Posterior pole color fundus photograph. Graded on the modified Davis scale. Without pupil dilation. 45 degree fundus photograph: 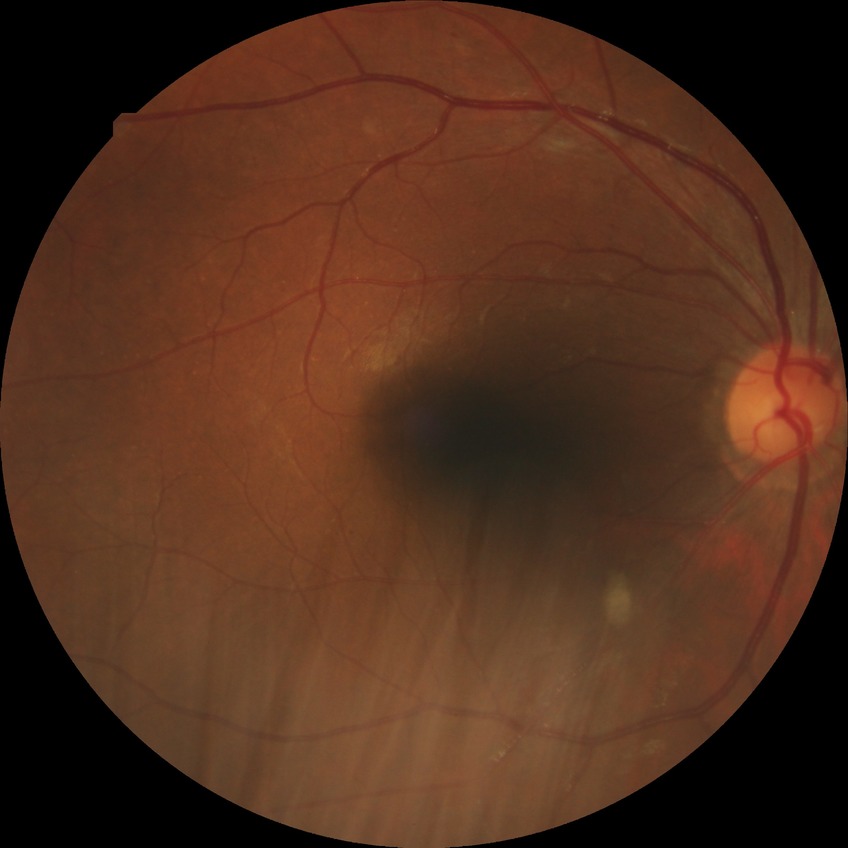 Diabetic retinopathy stage is simple diabetic retinopathy.